2184 by 1682 pixels · FOV: 45 degrees:
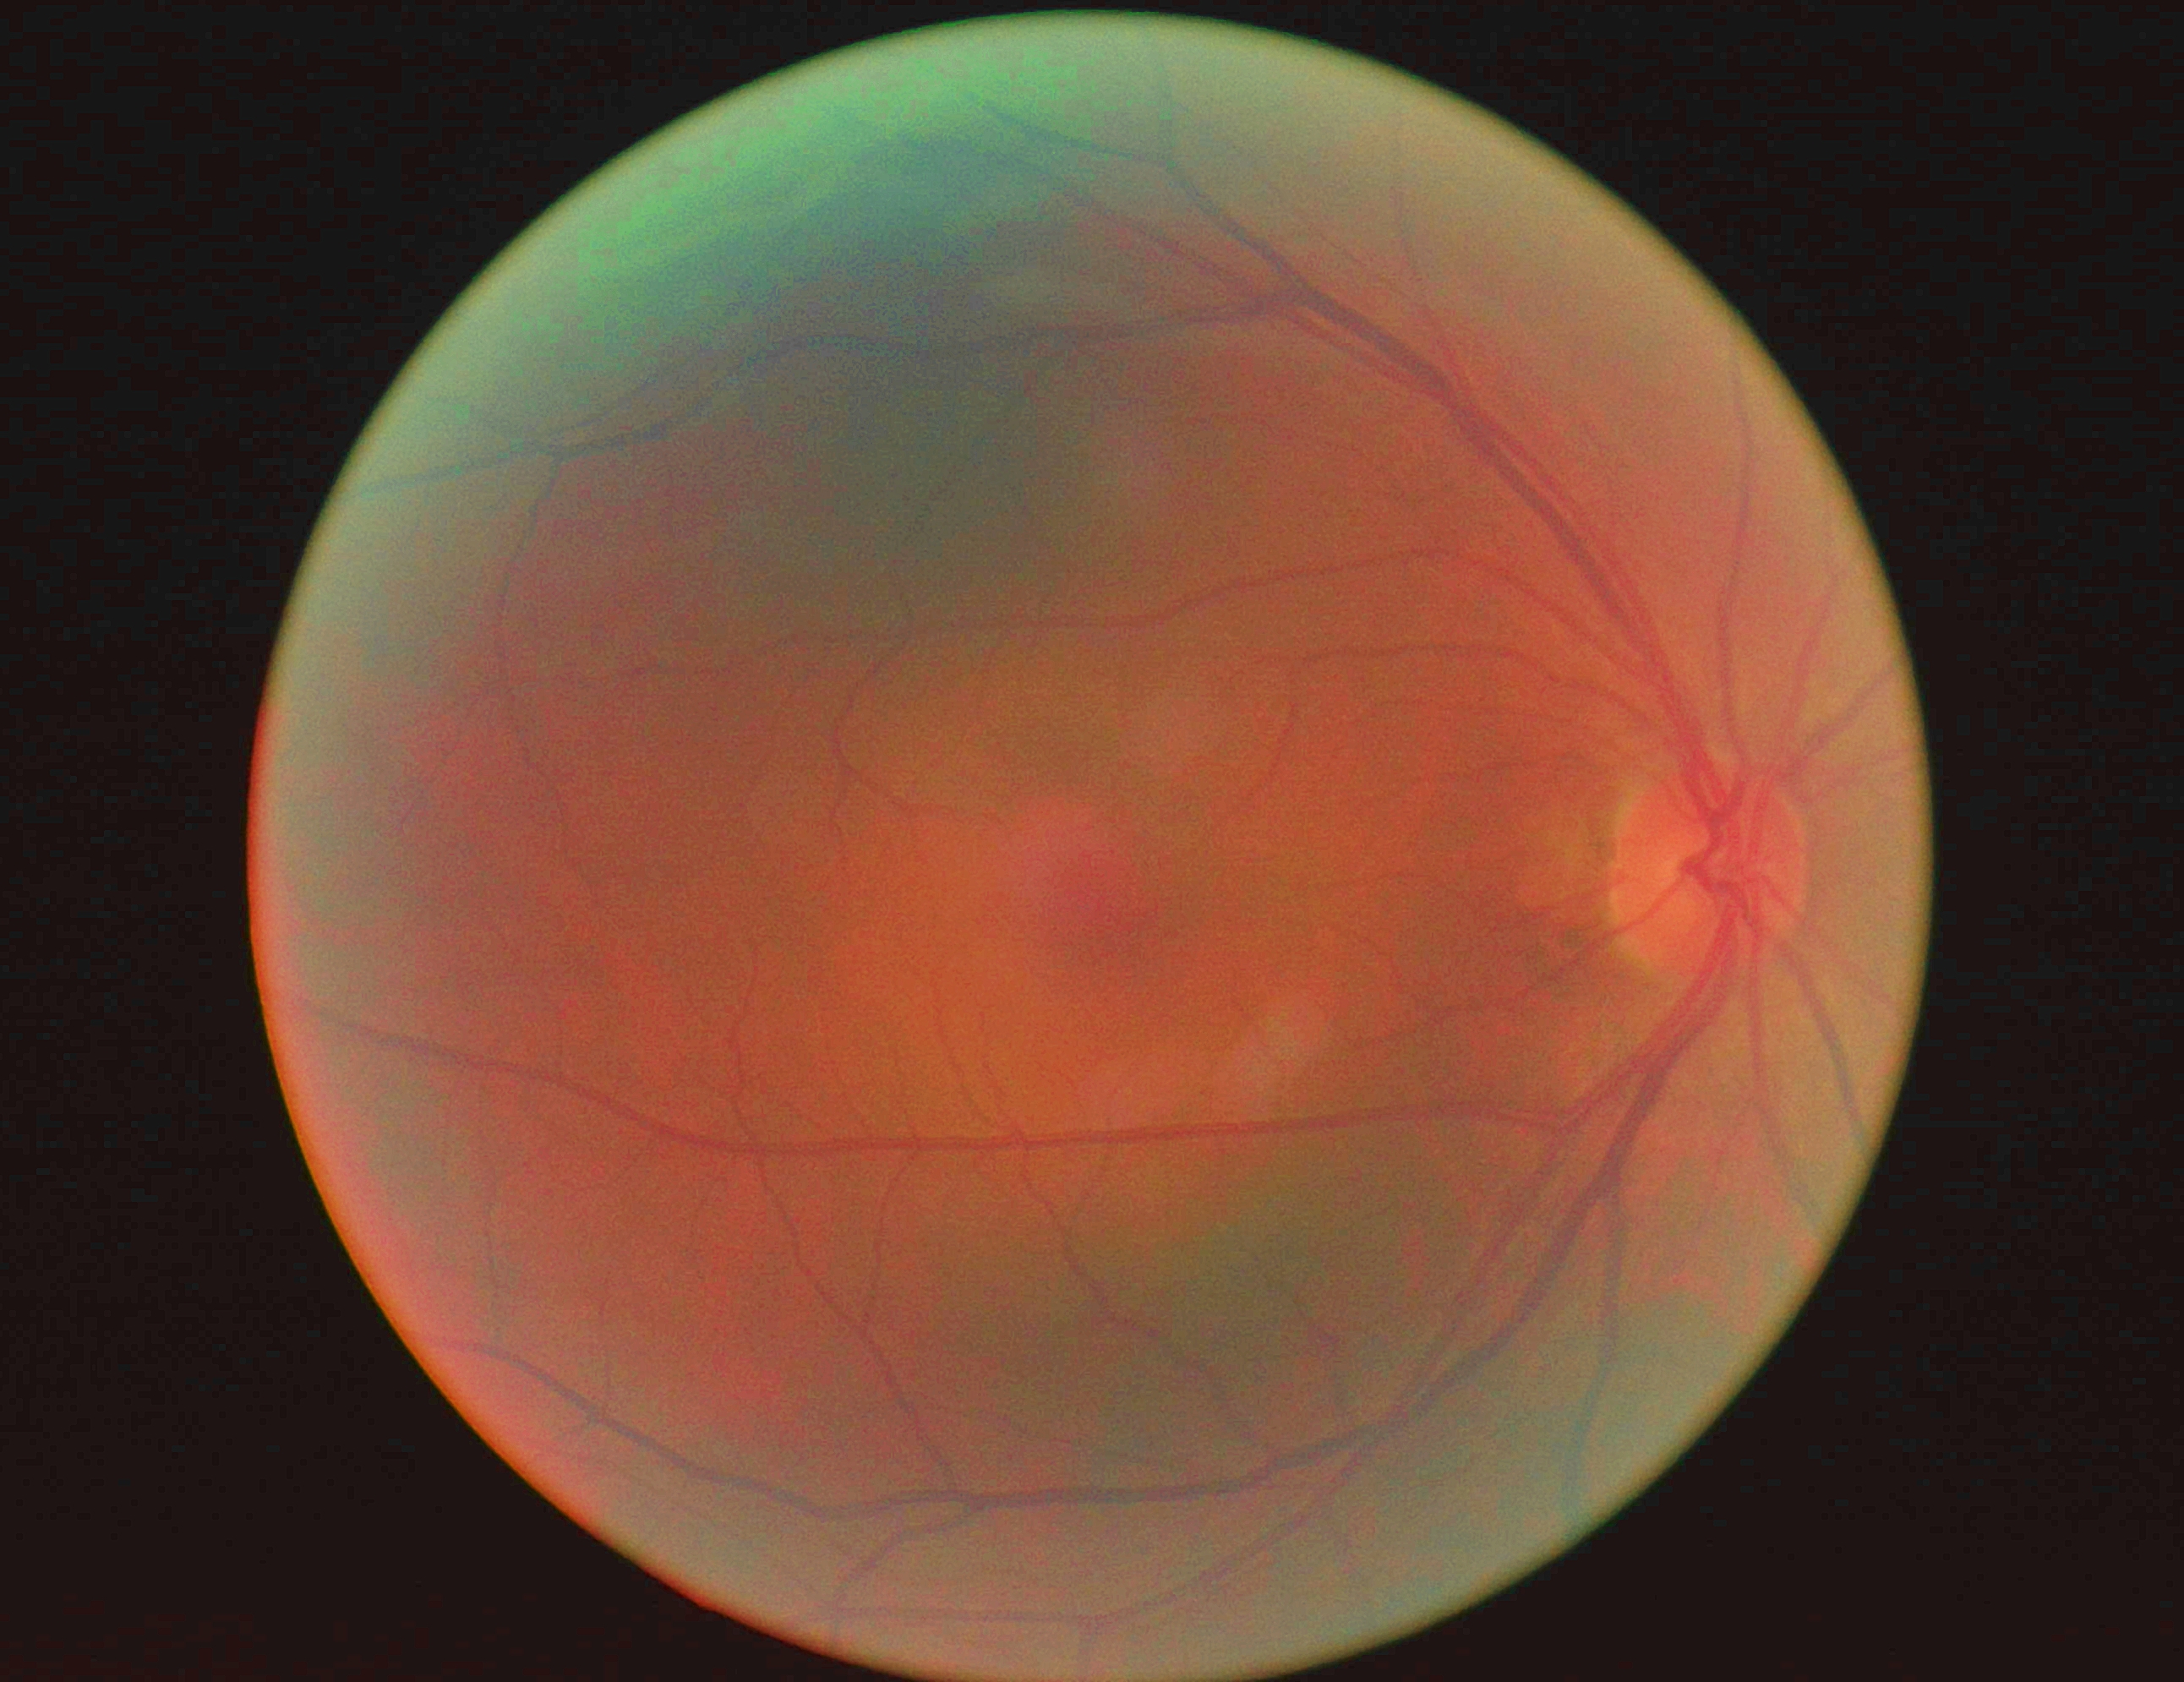
Diabetic retinopathy (DR): 0. No apparent diabetic retinopathy.